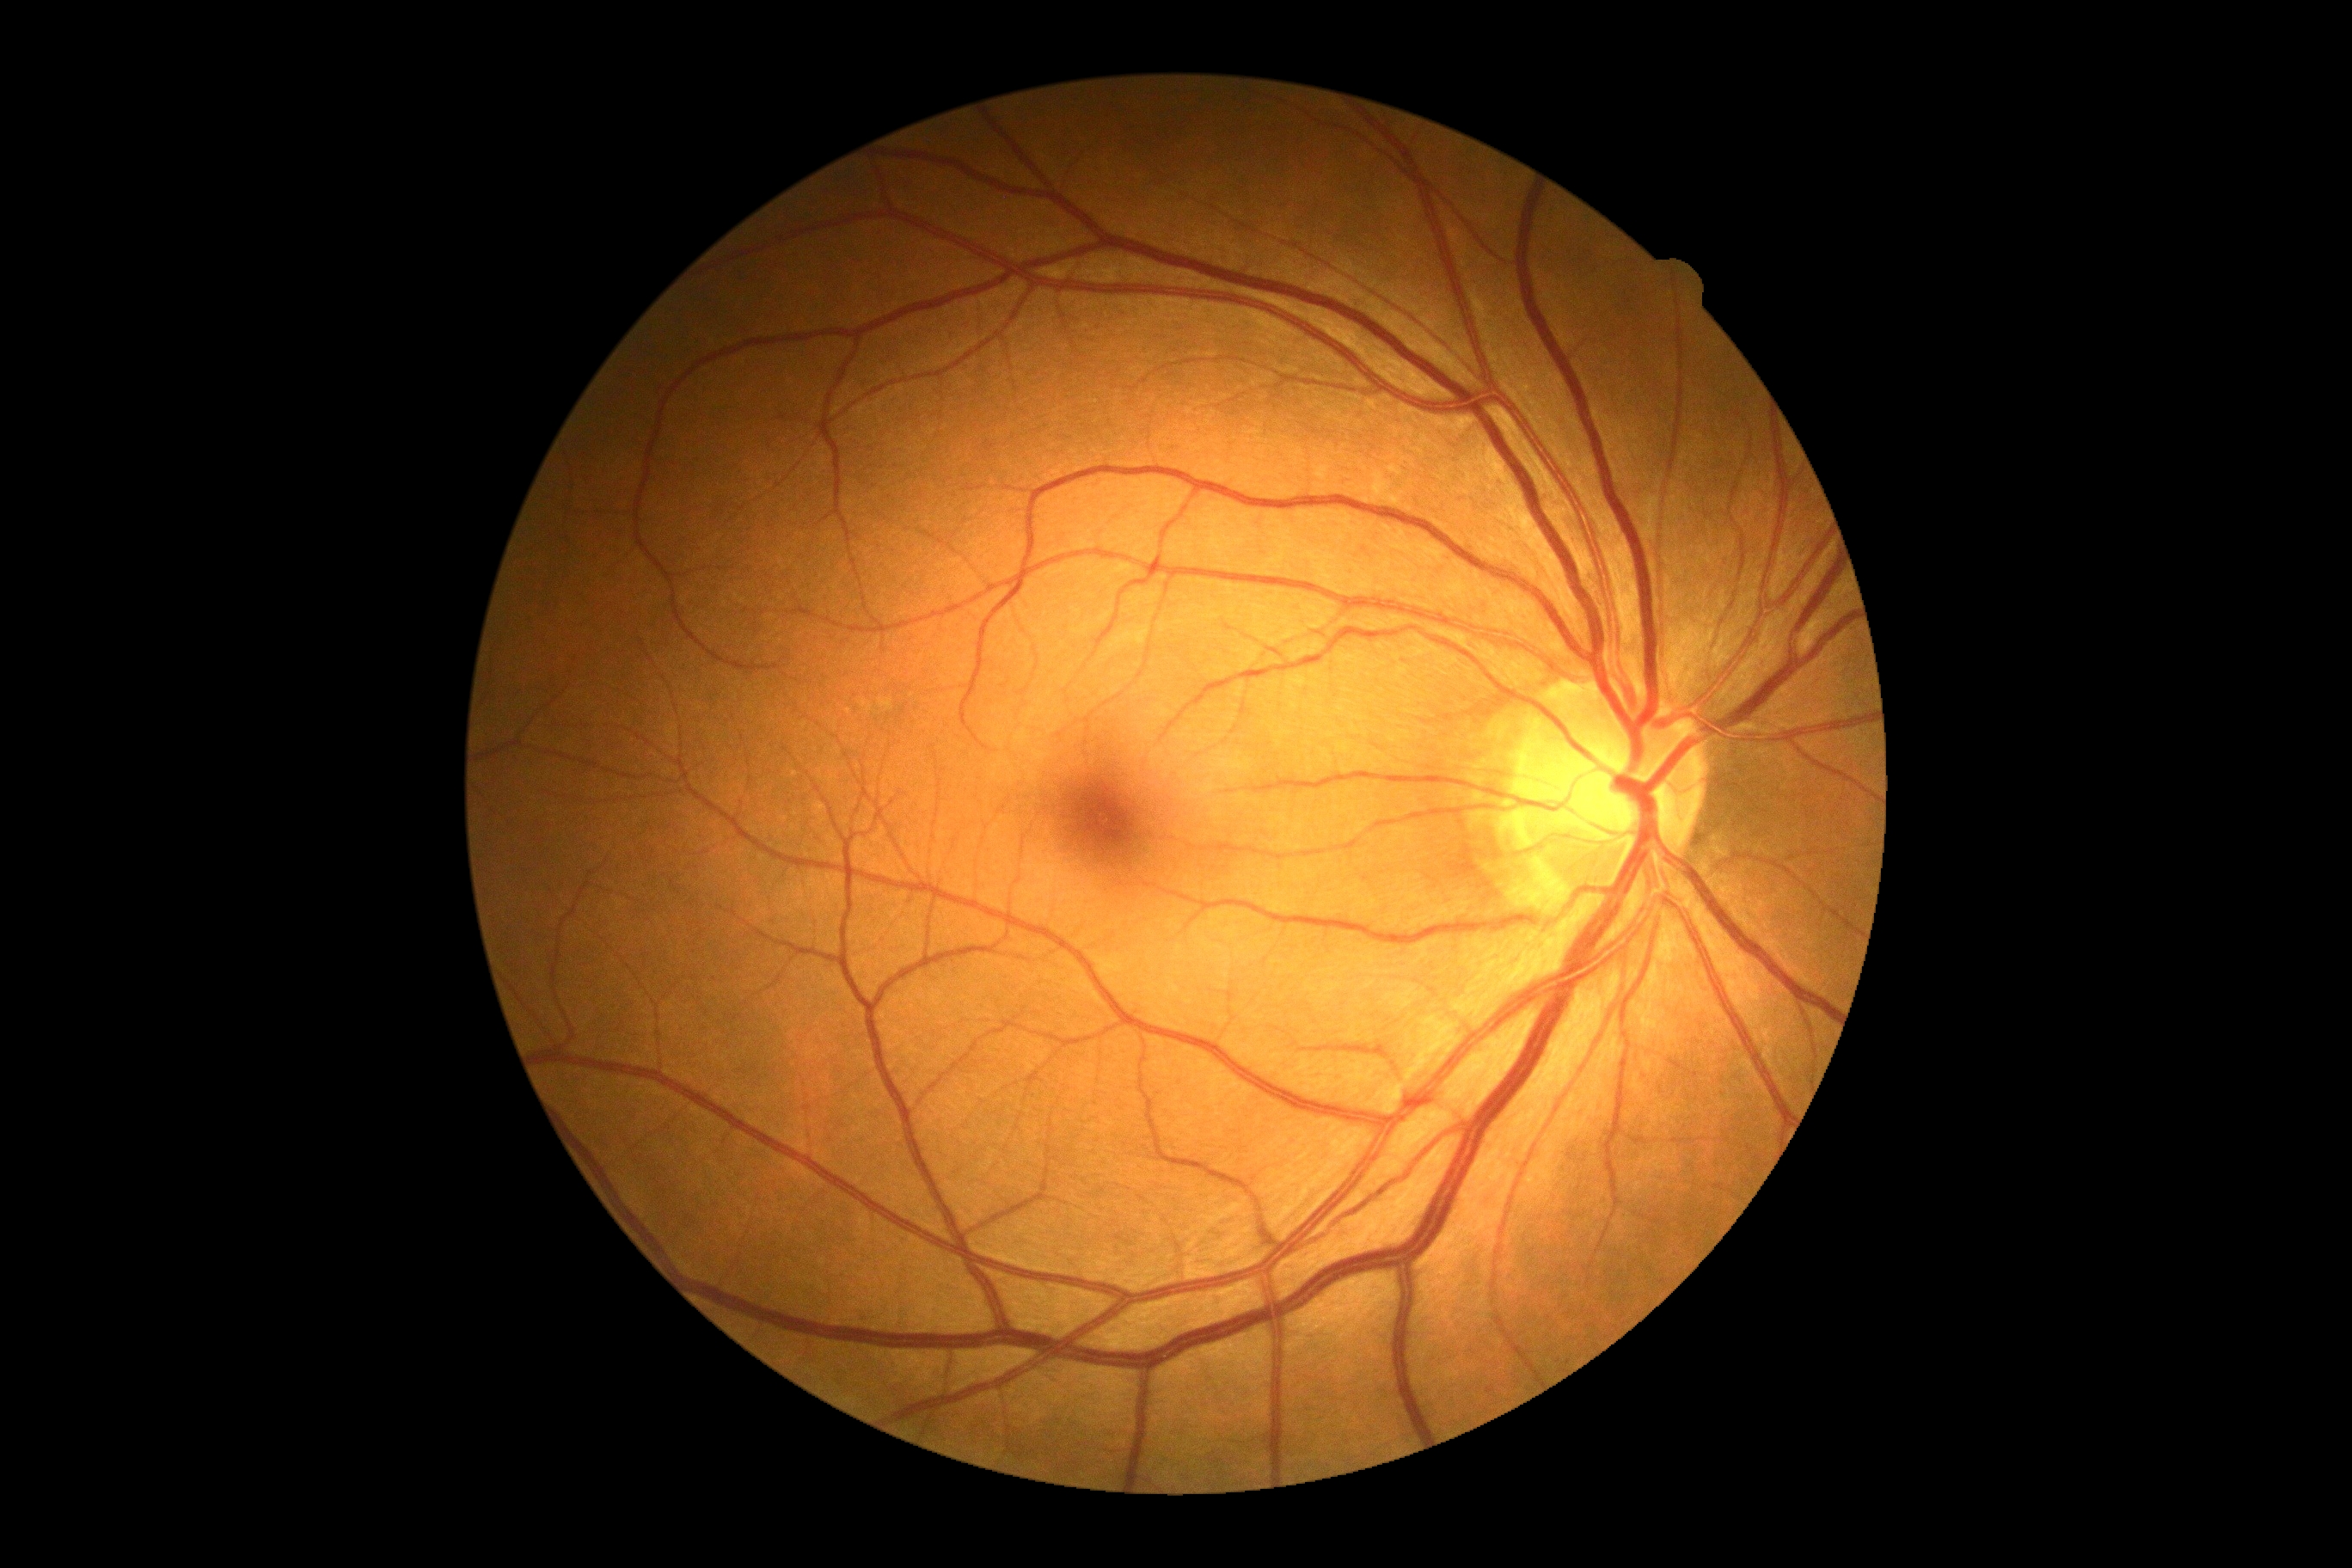

DR severity is 0.